Color fundus photograph; image size 2361x1568; FOV: 50 degrees:
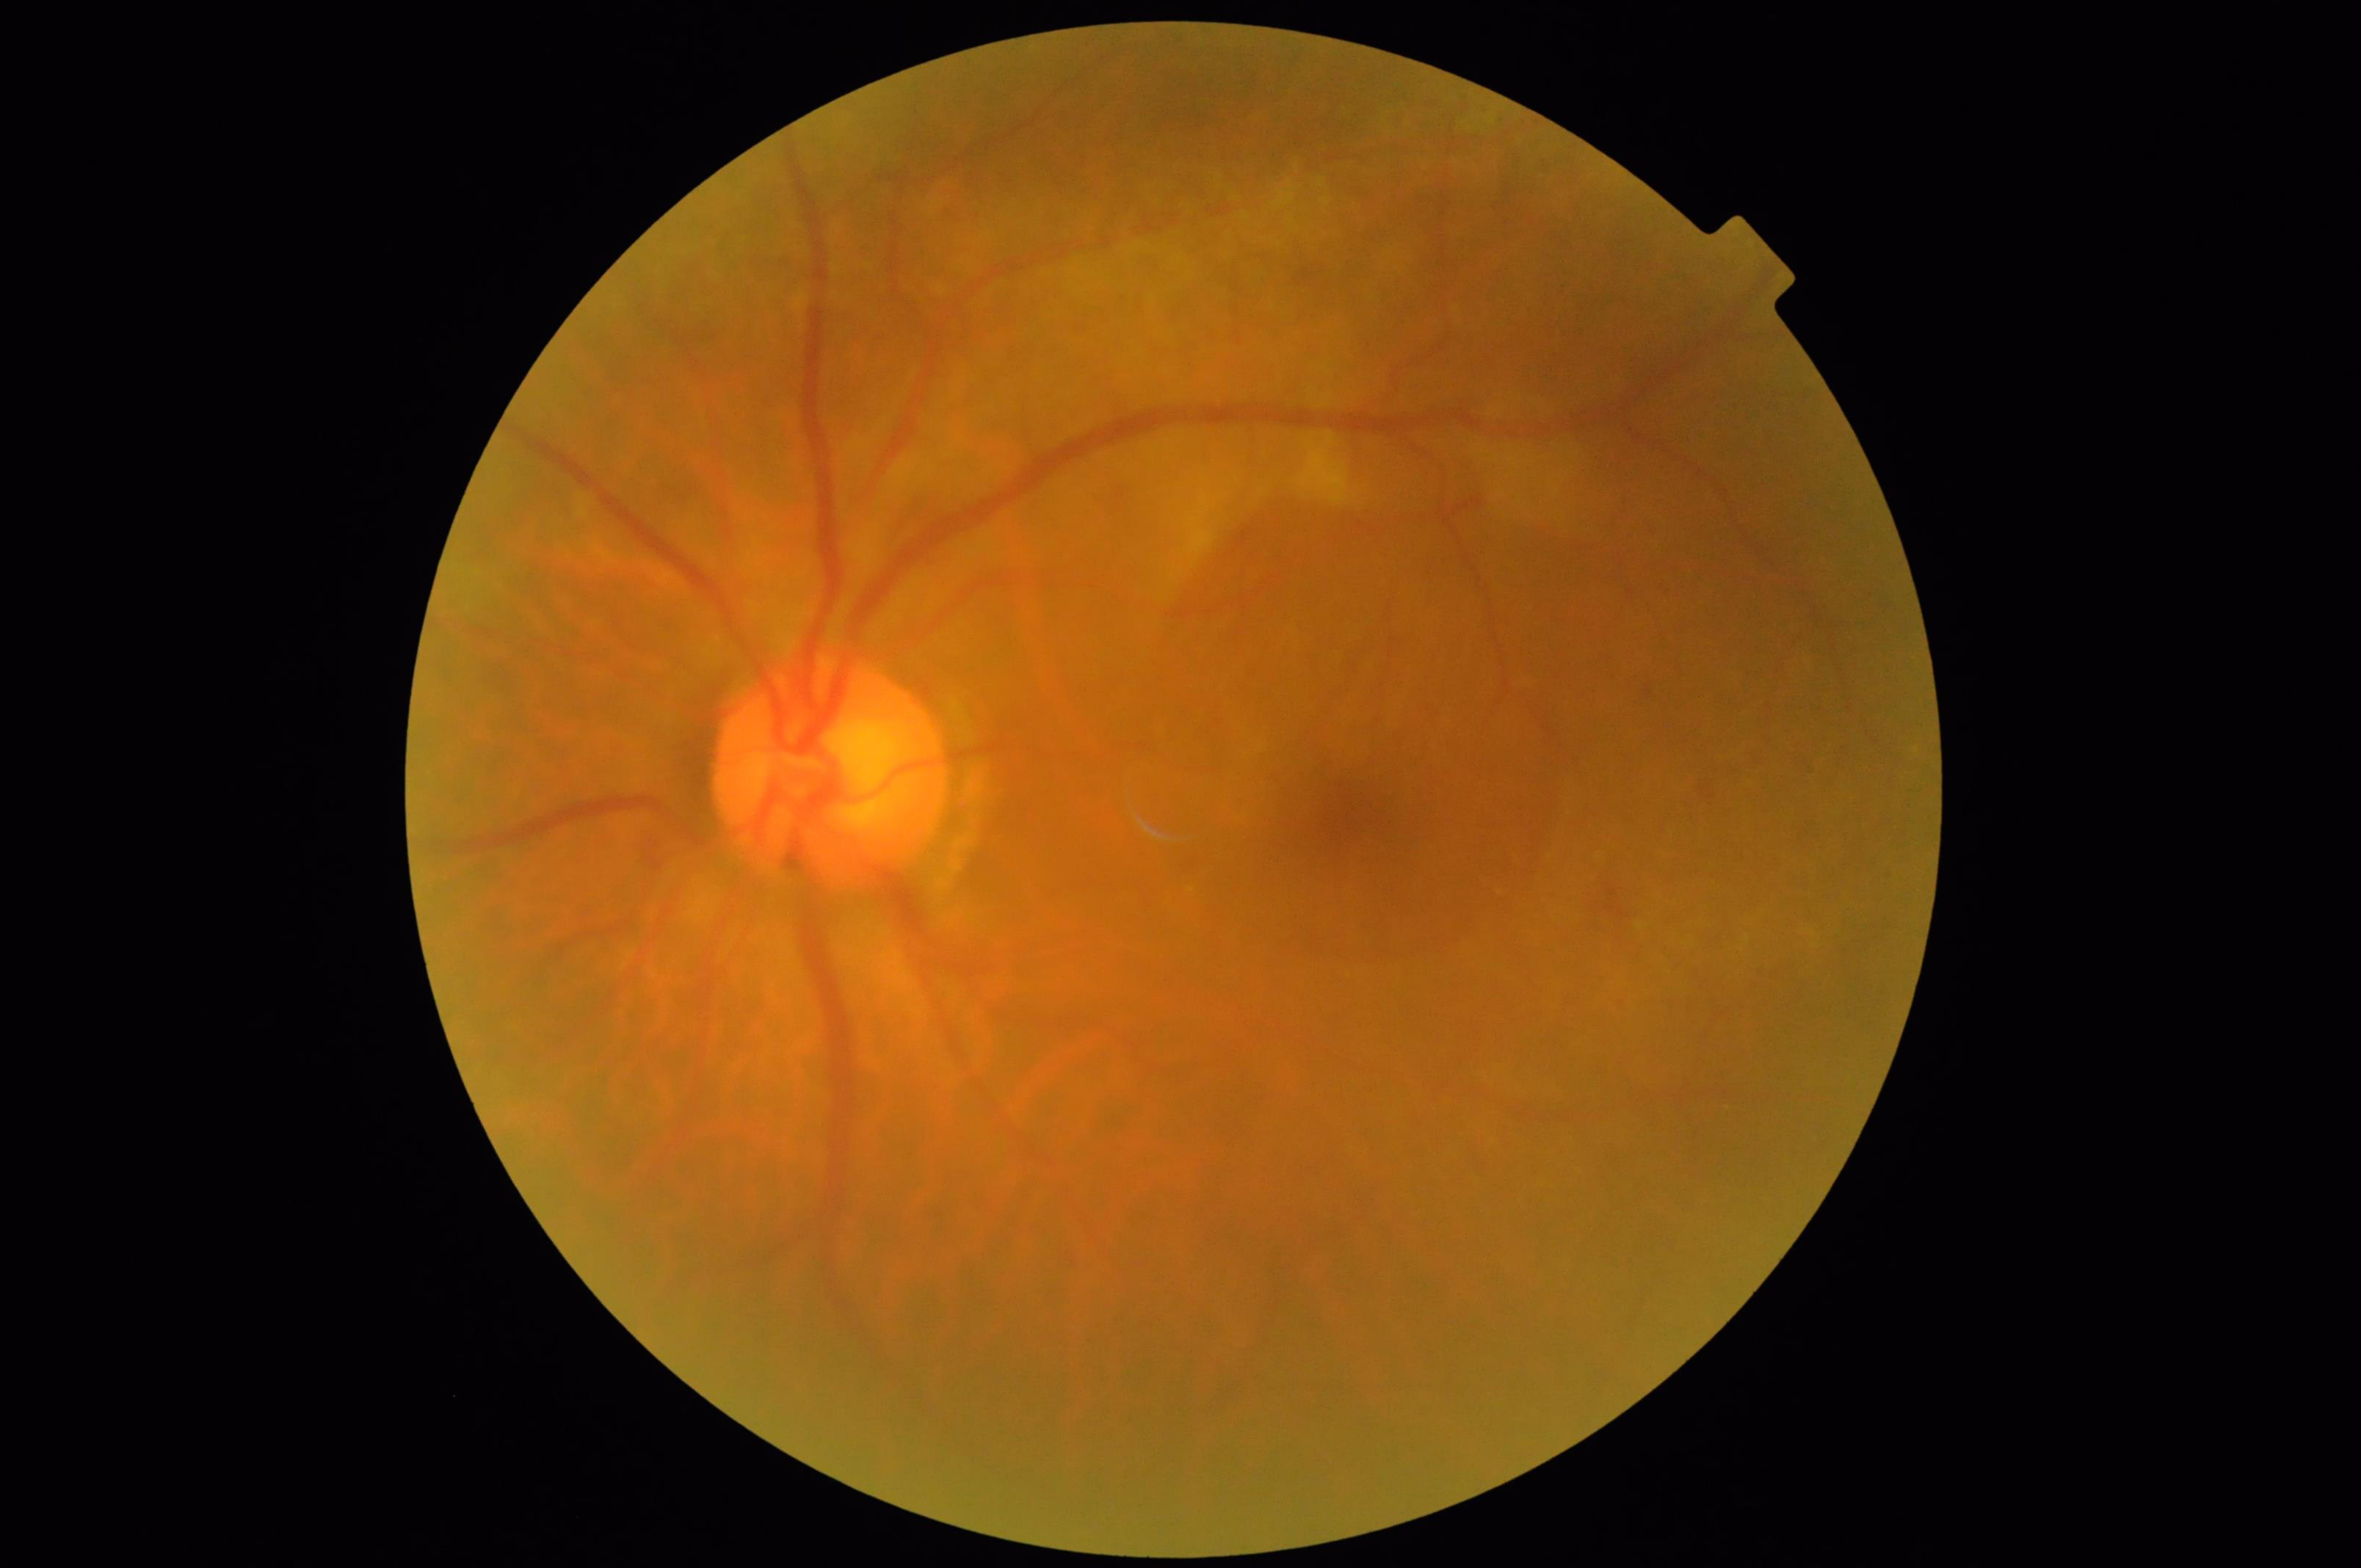
Image quality is inadequate for diagnostic use. Noticeable blur in the optic disc, vessels, or background. Even illumination with no color cast. Contrast is low.